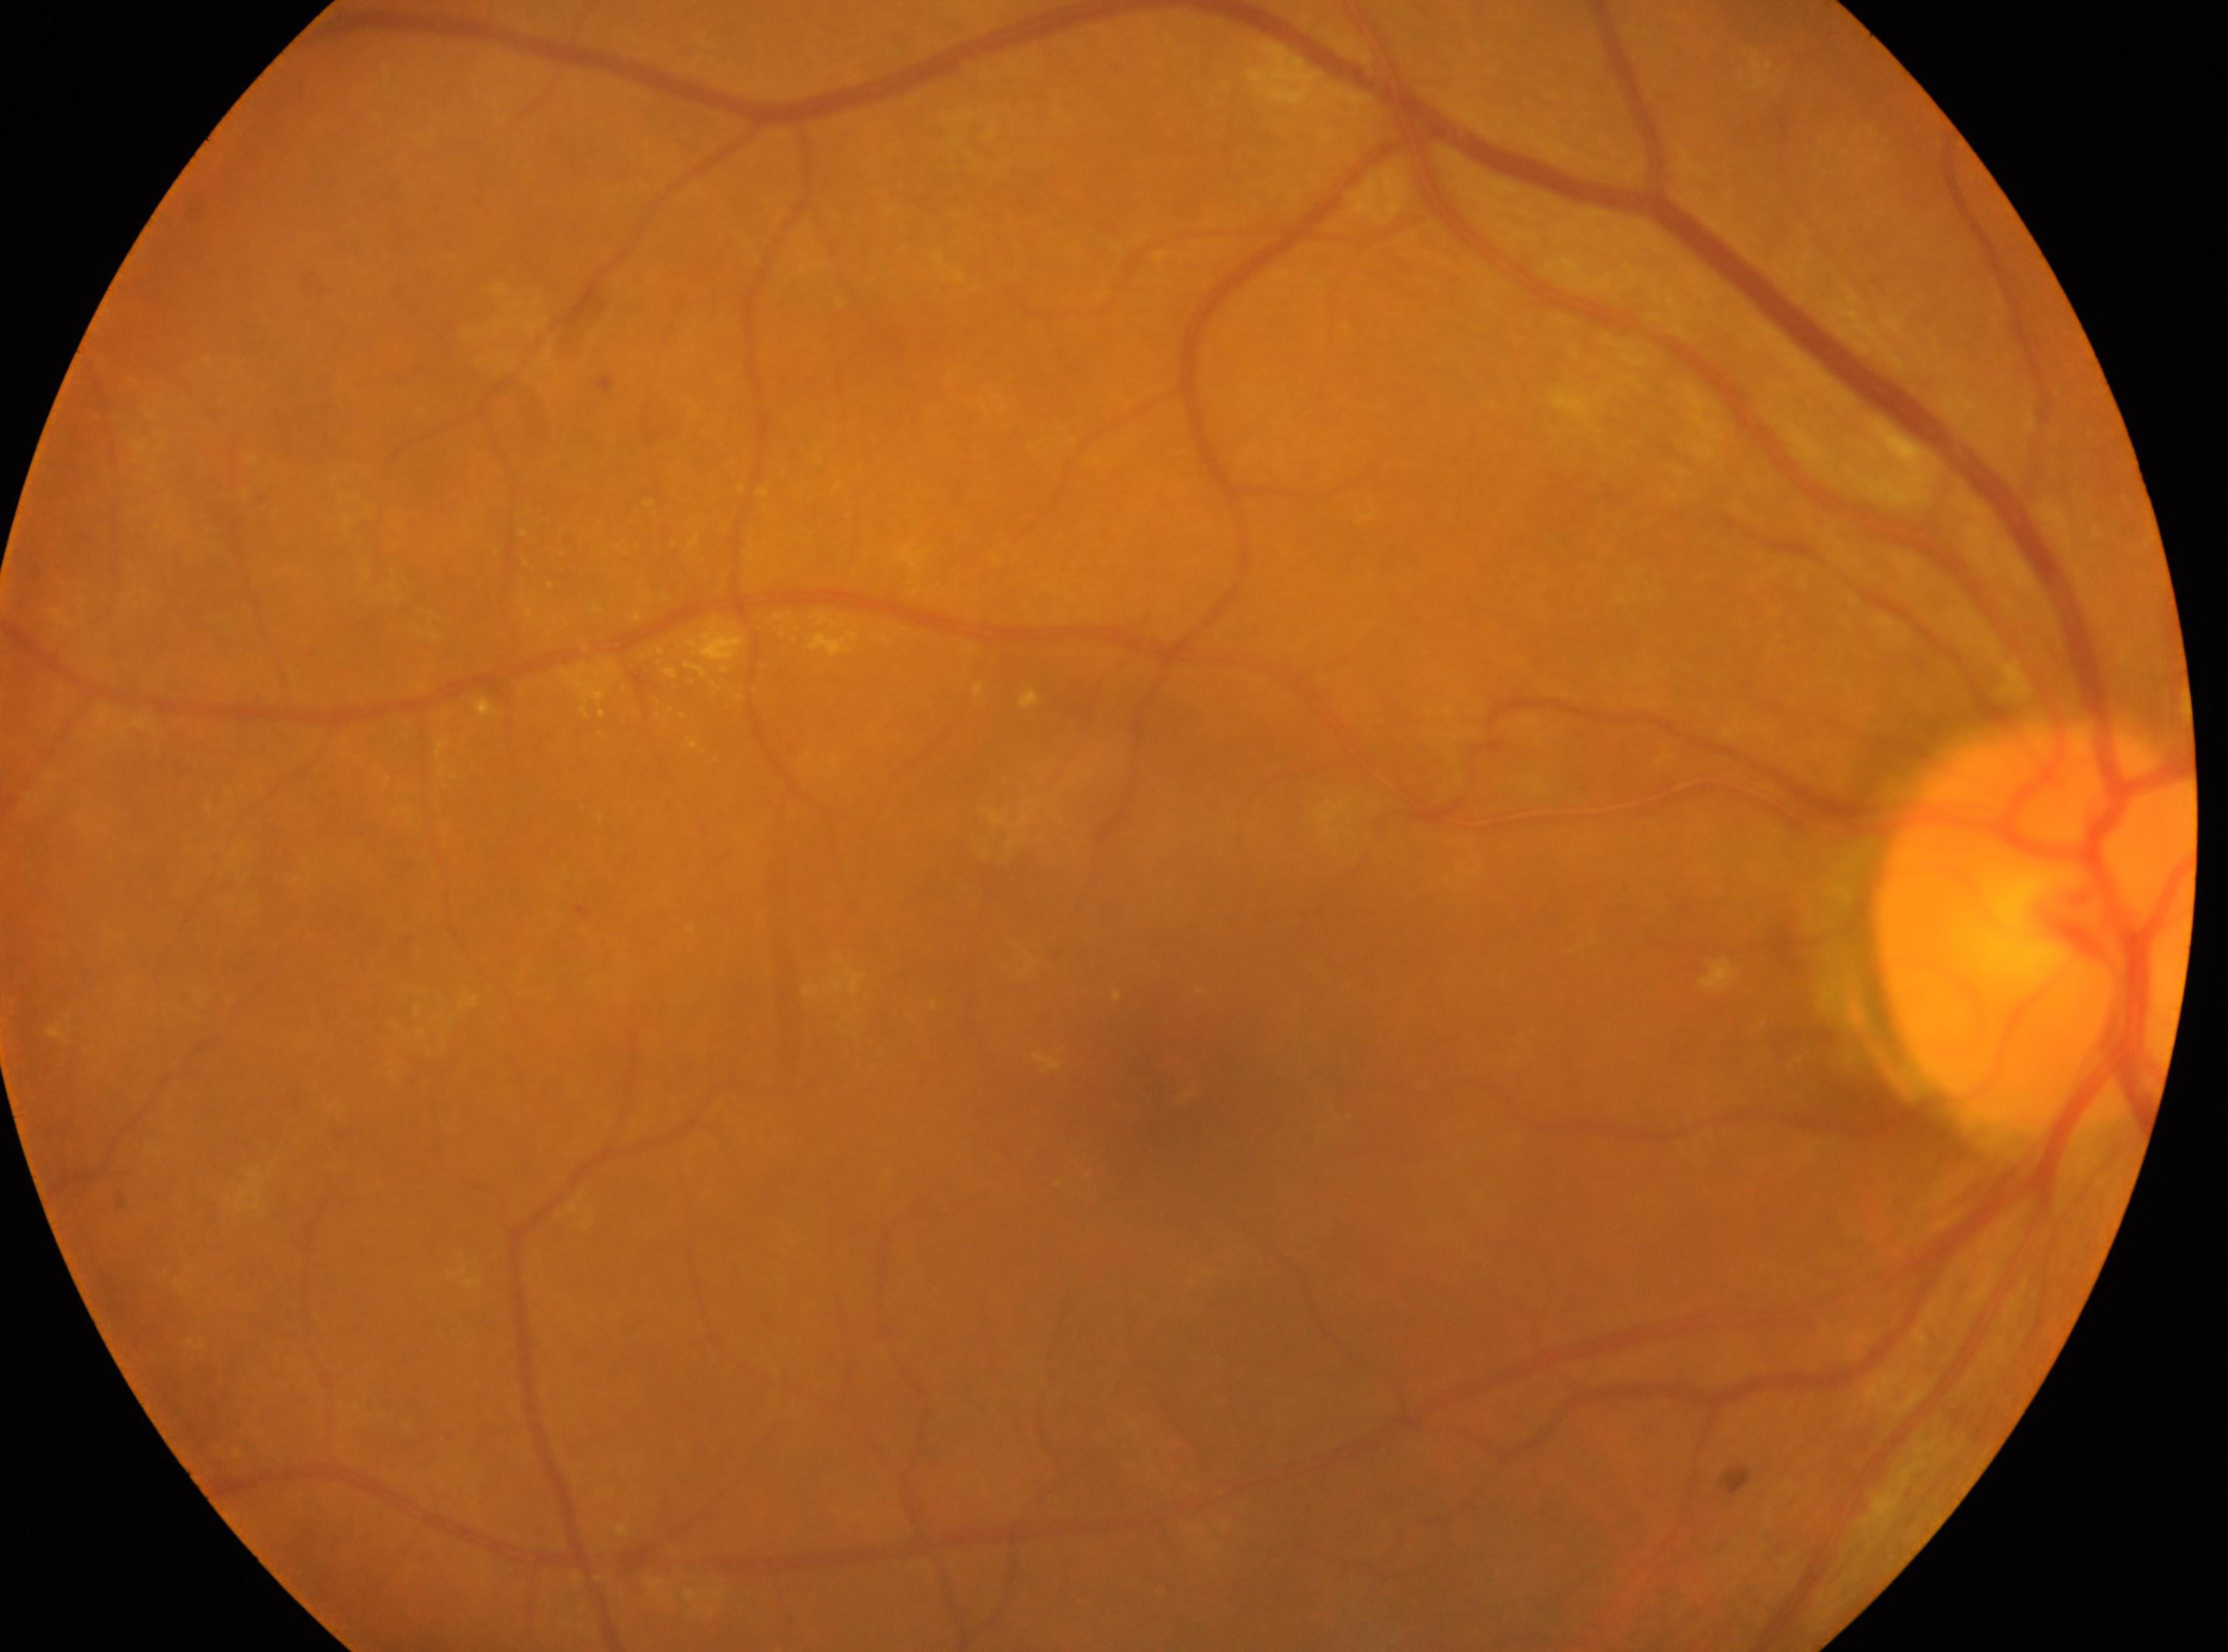

Findings:
– macula center — (x=1160, y=1061)
– eye — OD
– diabetic retinopathy severity — 2
– optic nerve head — (x=2035, y=923)